Retinal fundus photograph:
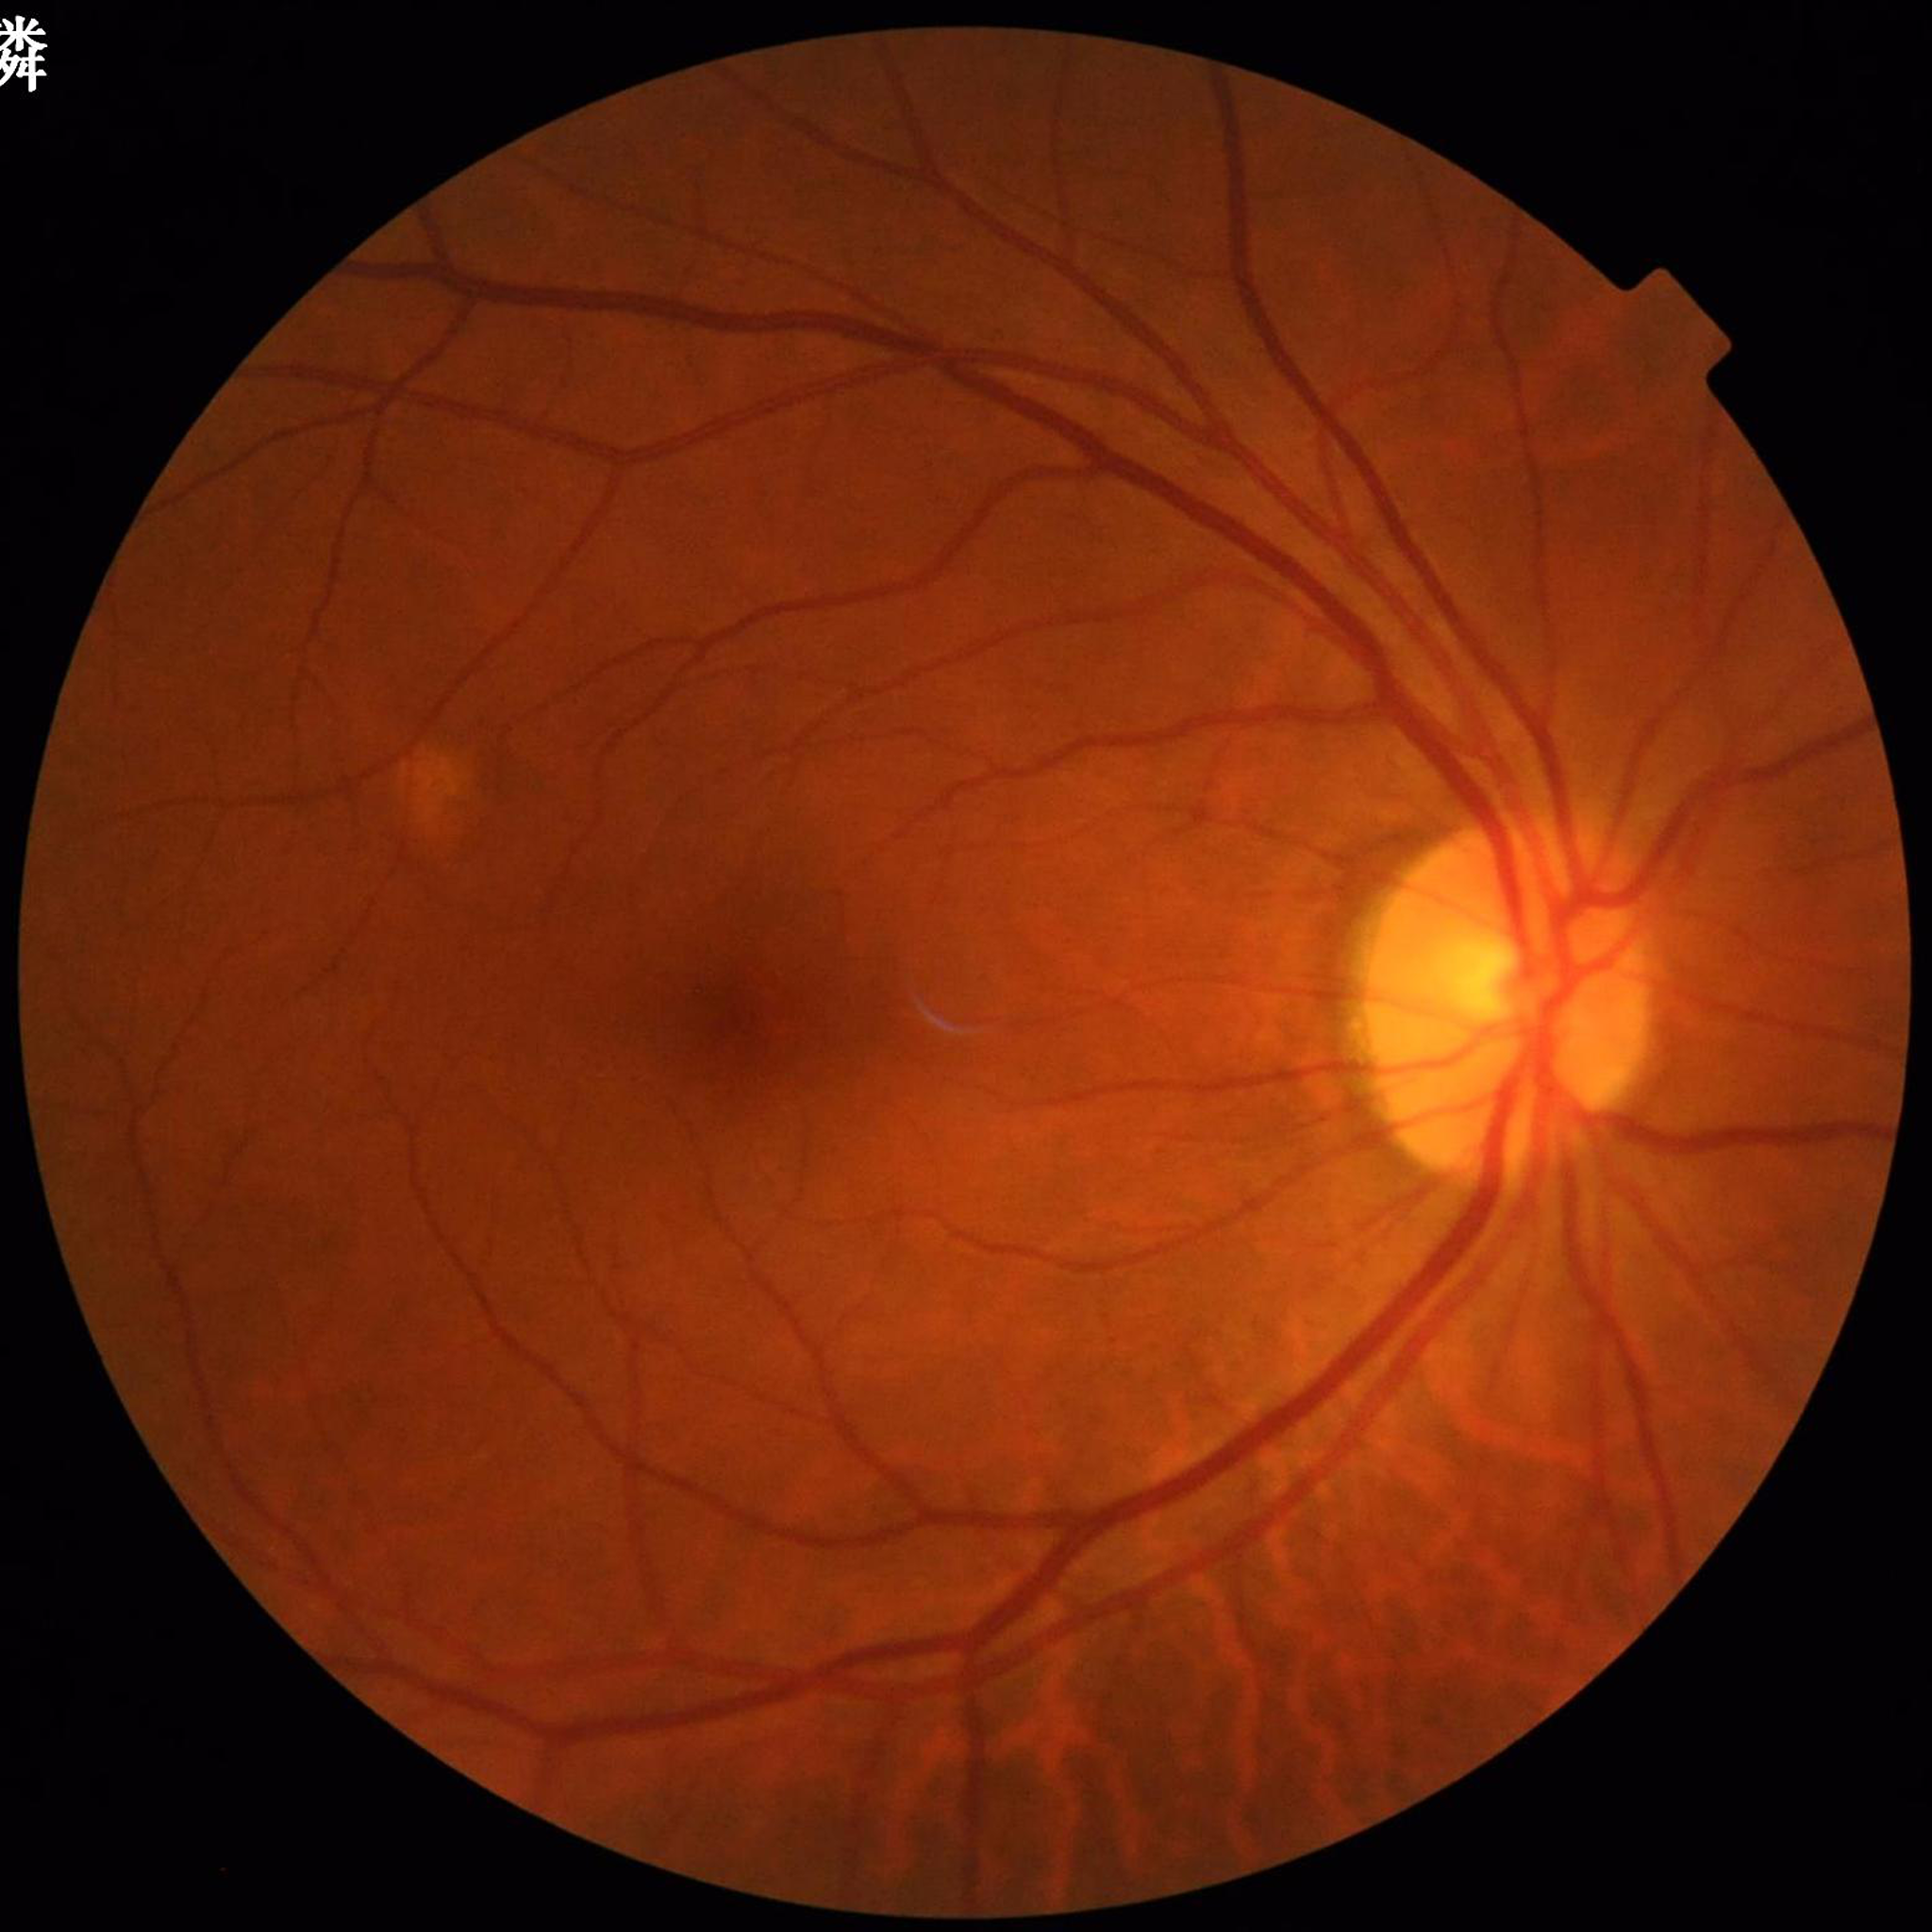

Automated quality assessment: satisfactory. Eye affected by glaucoma.